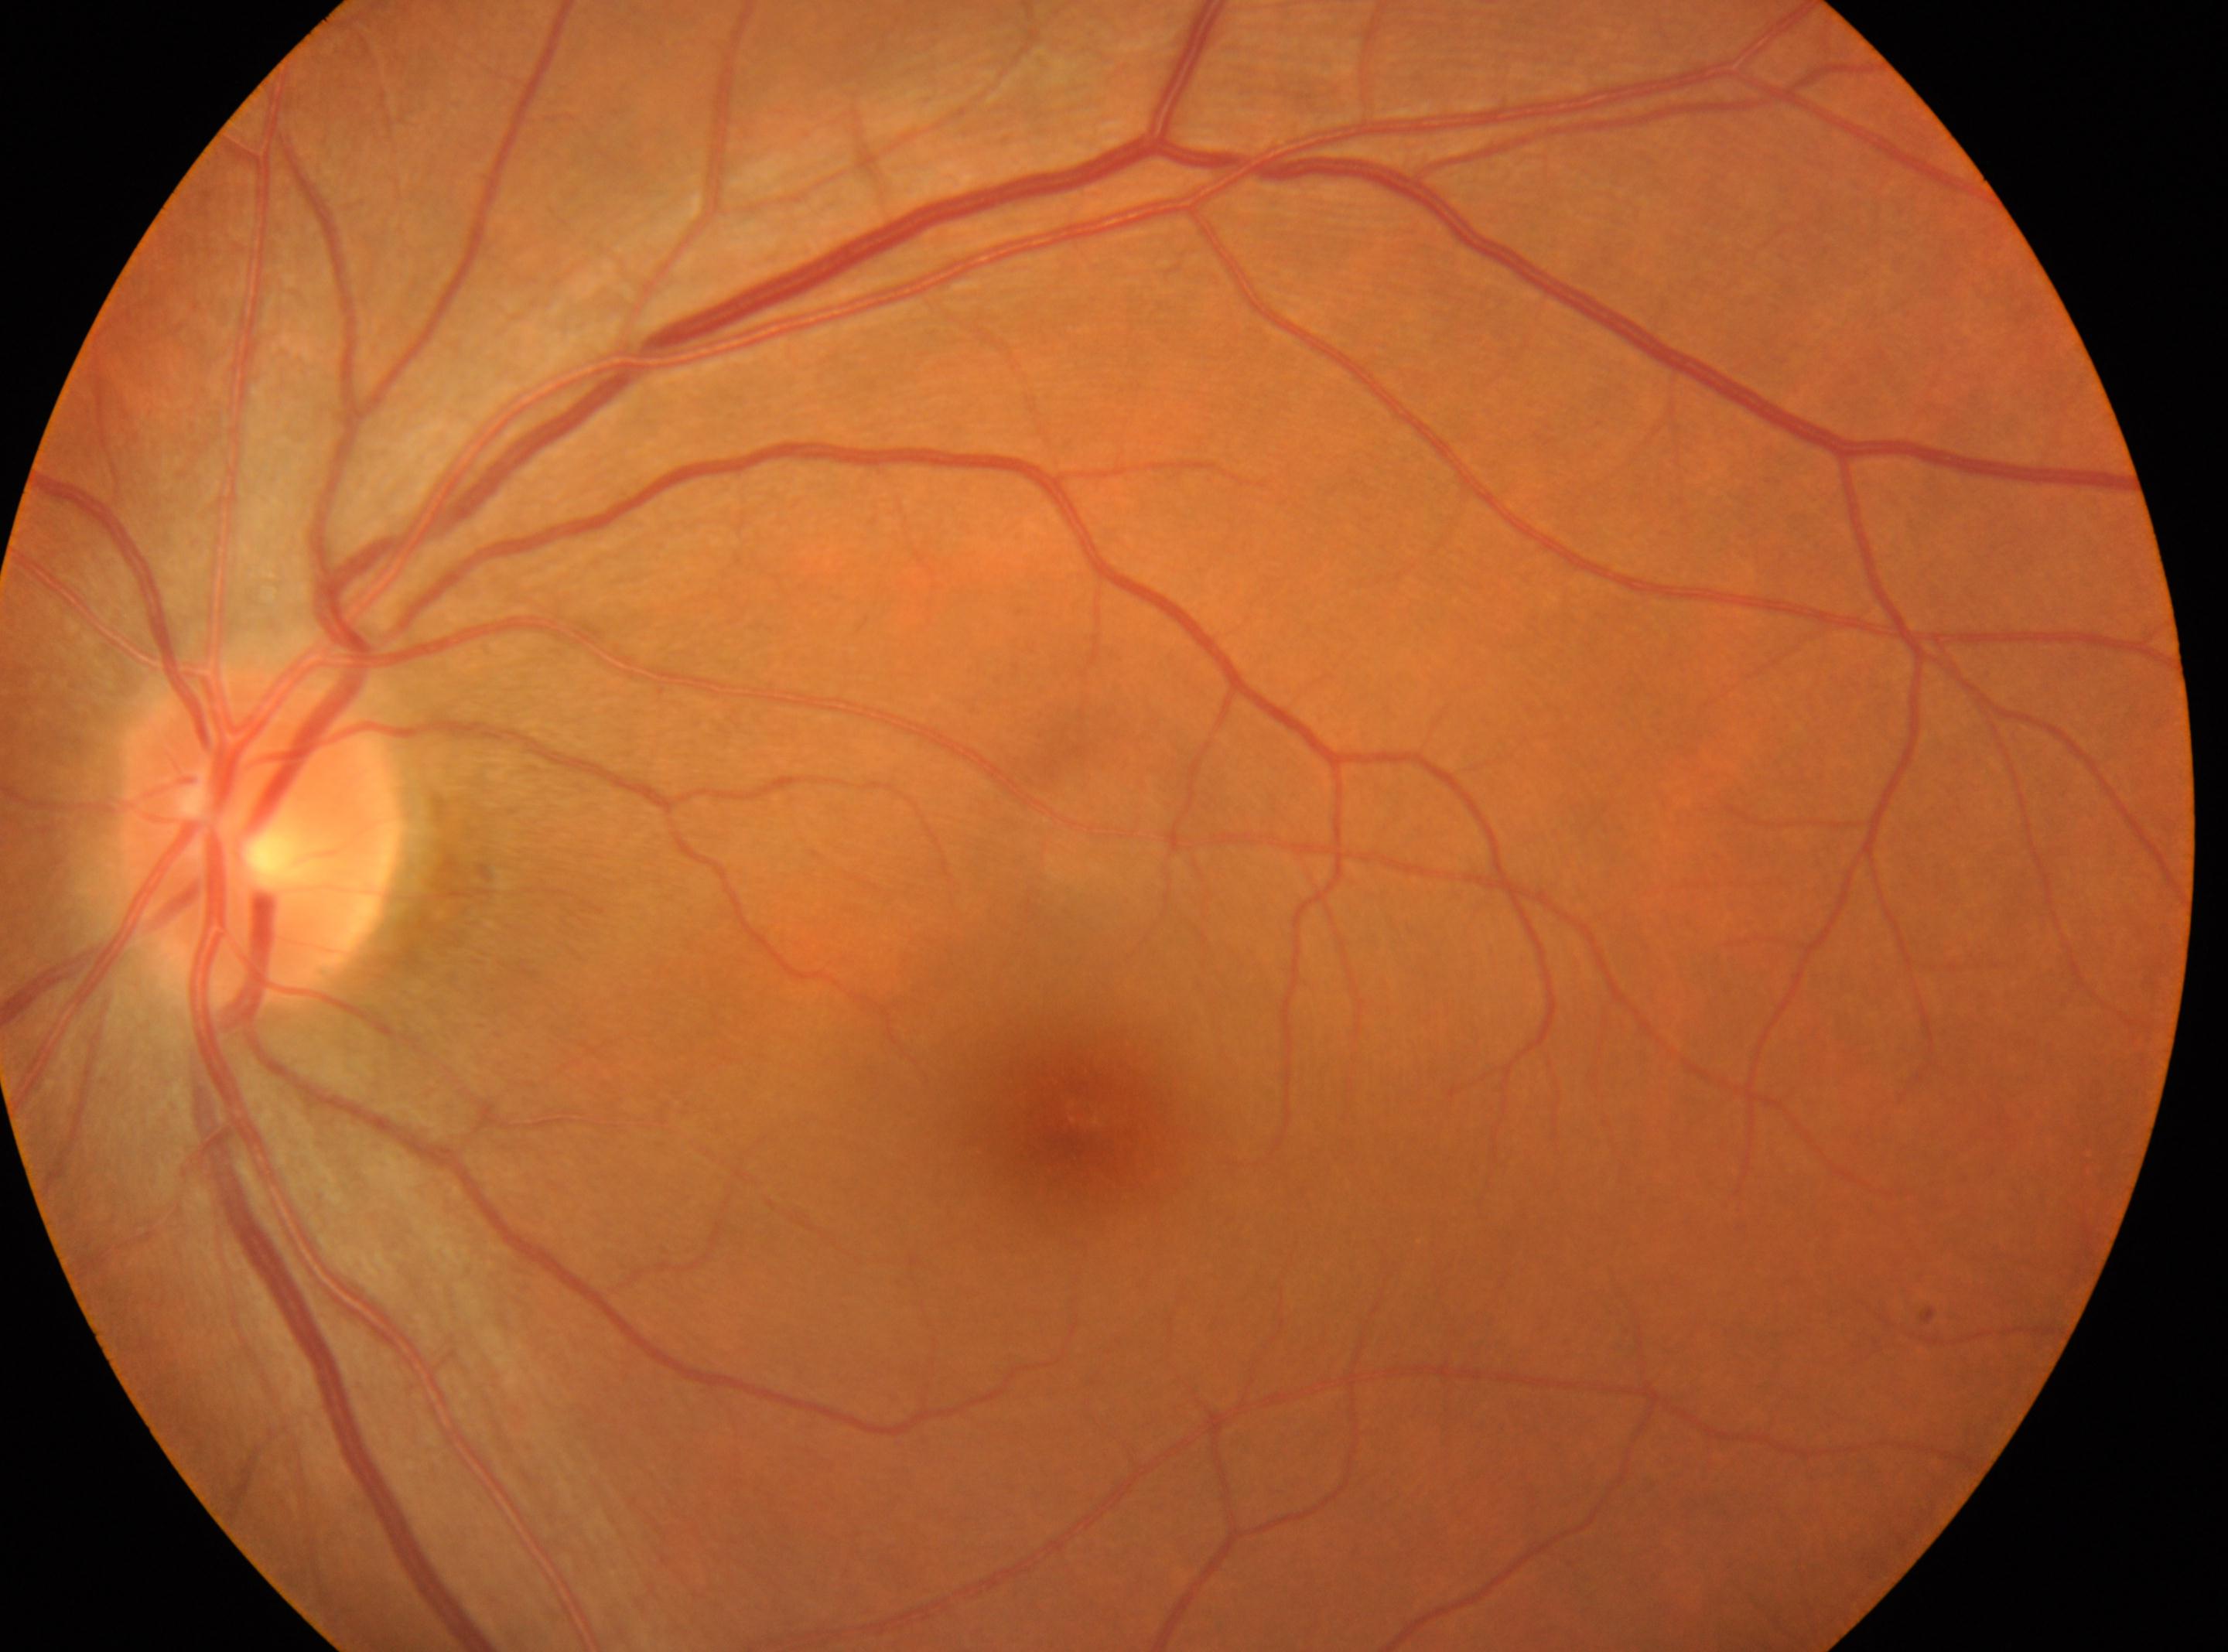 The optic disc is at 260px, 834px. DR grade is no apparent retinopathy (0). The macula center is at 1078px, 1120px. No apparent diabetic retinopathy. This is the oculus sinister.